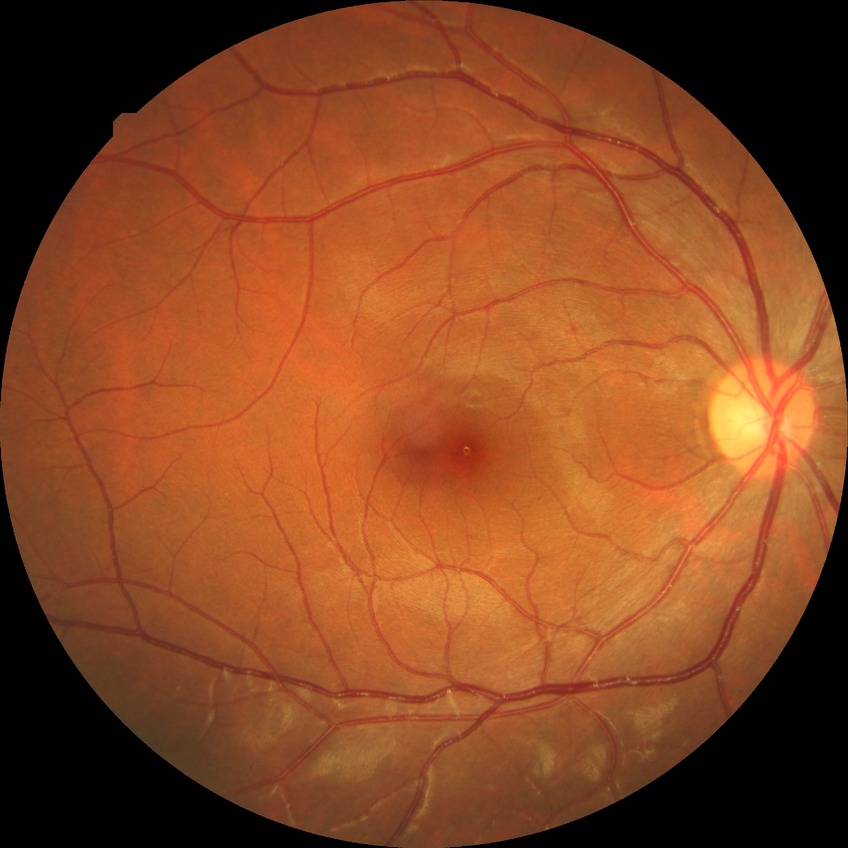
retinopathy grade: no diabetic retinopathy.